Image size 1240x1240; pediatric wide-field fundus photograph.
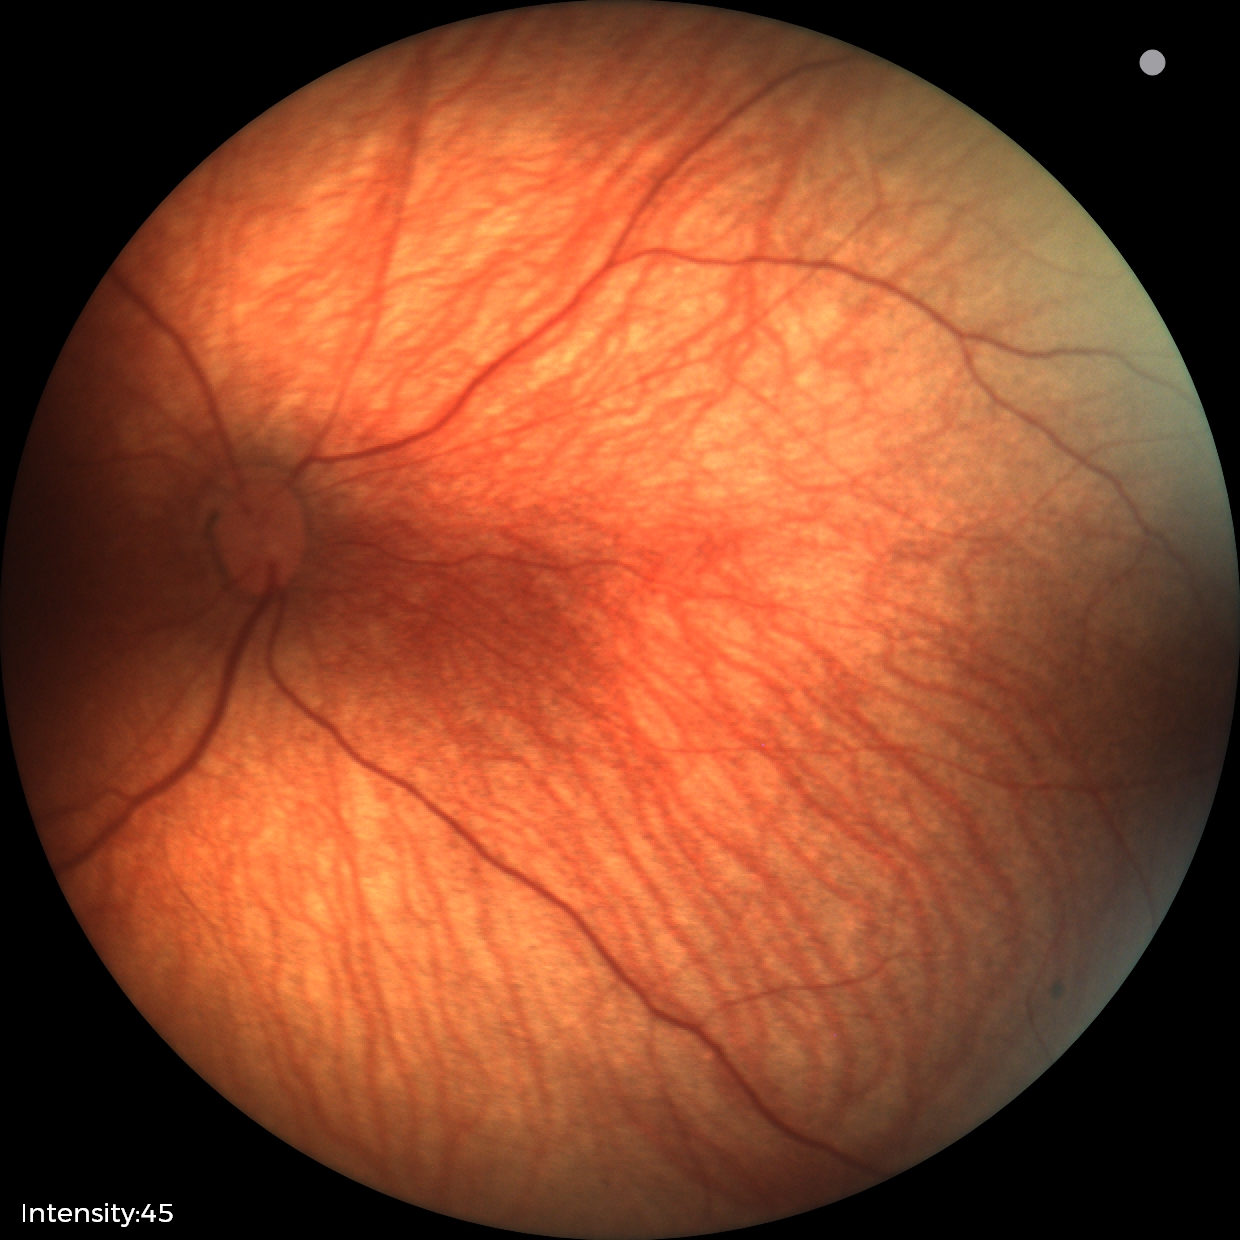

Physiological retinal appearance for postconceptual age.